Fundus photo — 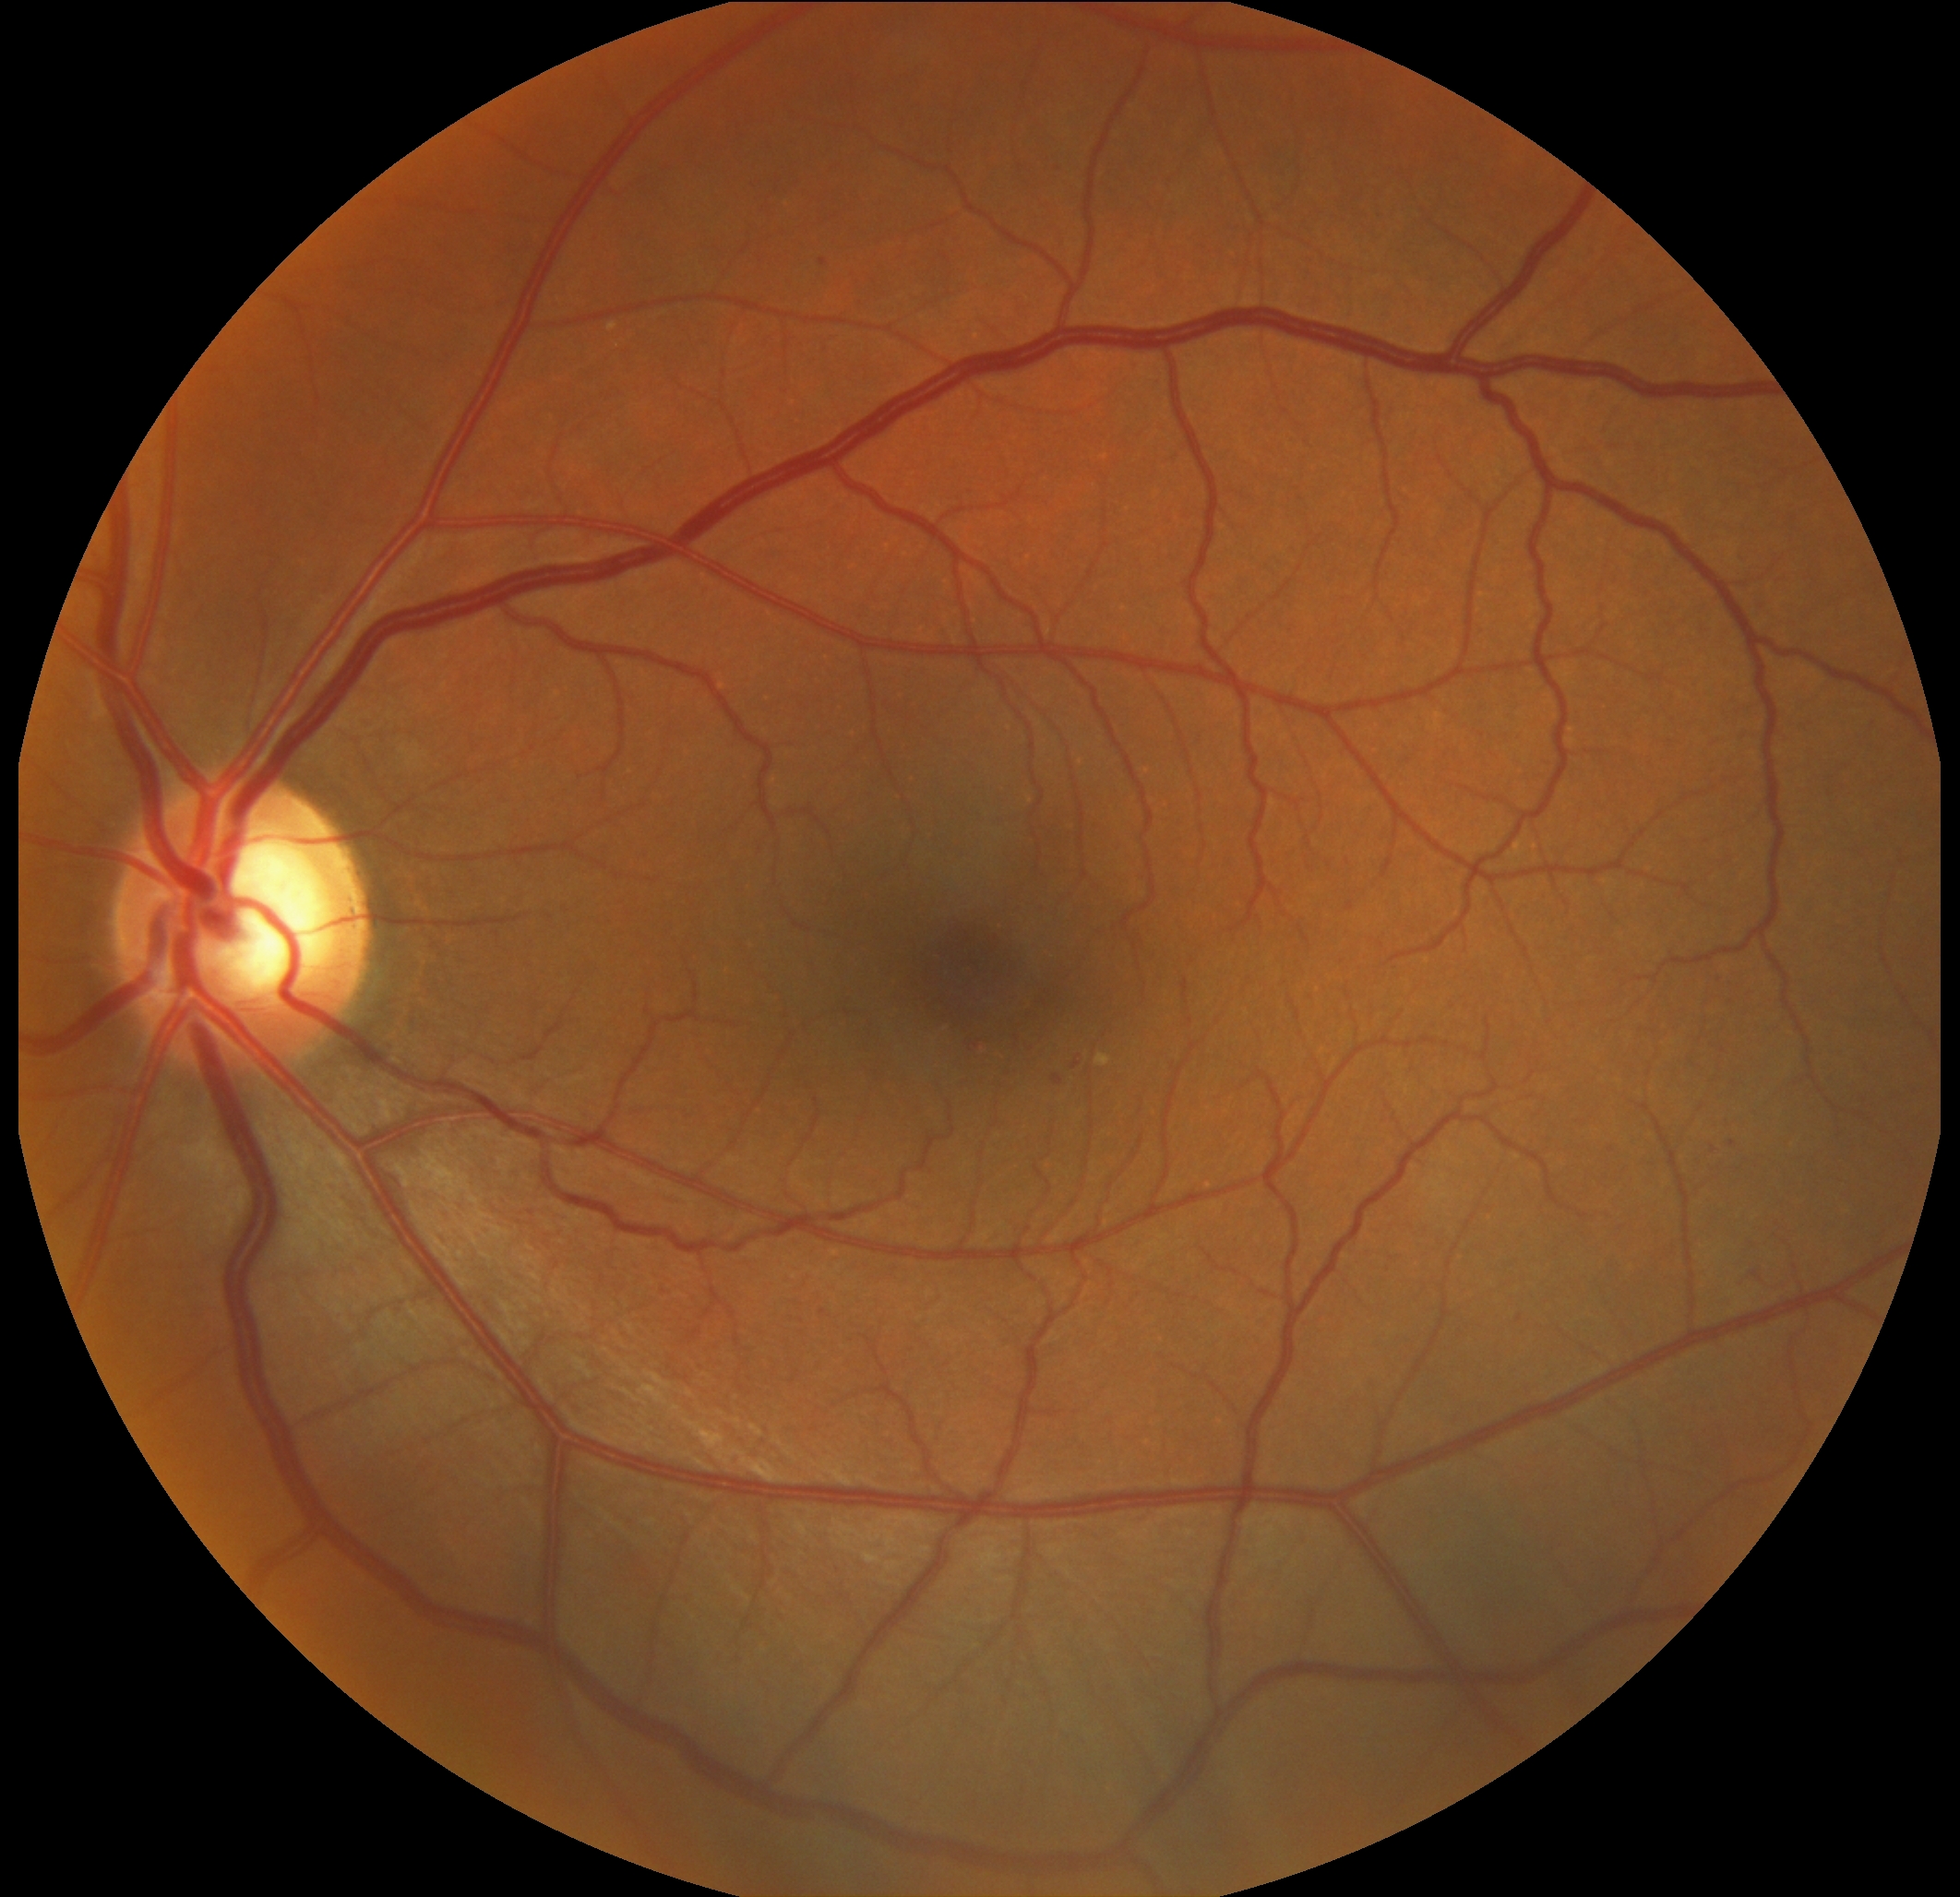
Diabetic retinopathy (DR) is 2 — more than just microaneurysms but less than severe NPDR.